Diabetic retinopathy graded by the modified Davis classification.
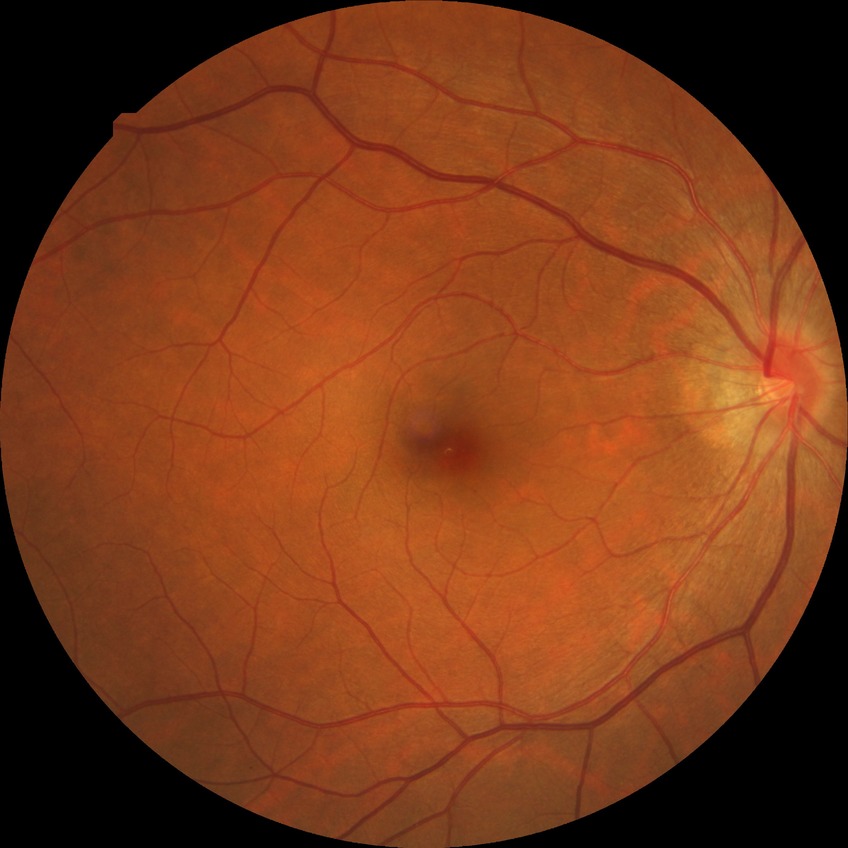
modified Davis classification@no diabetic retinopathy.